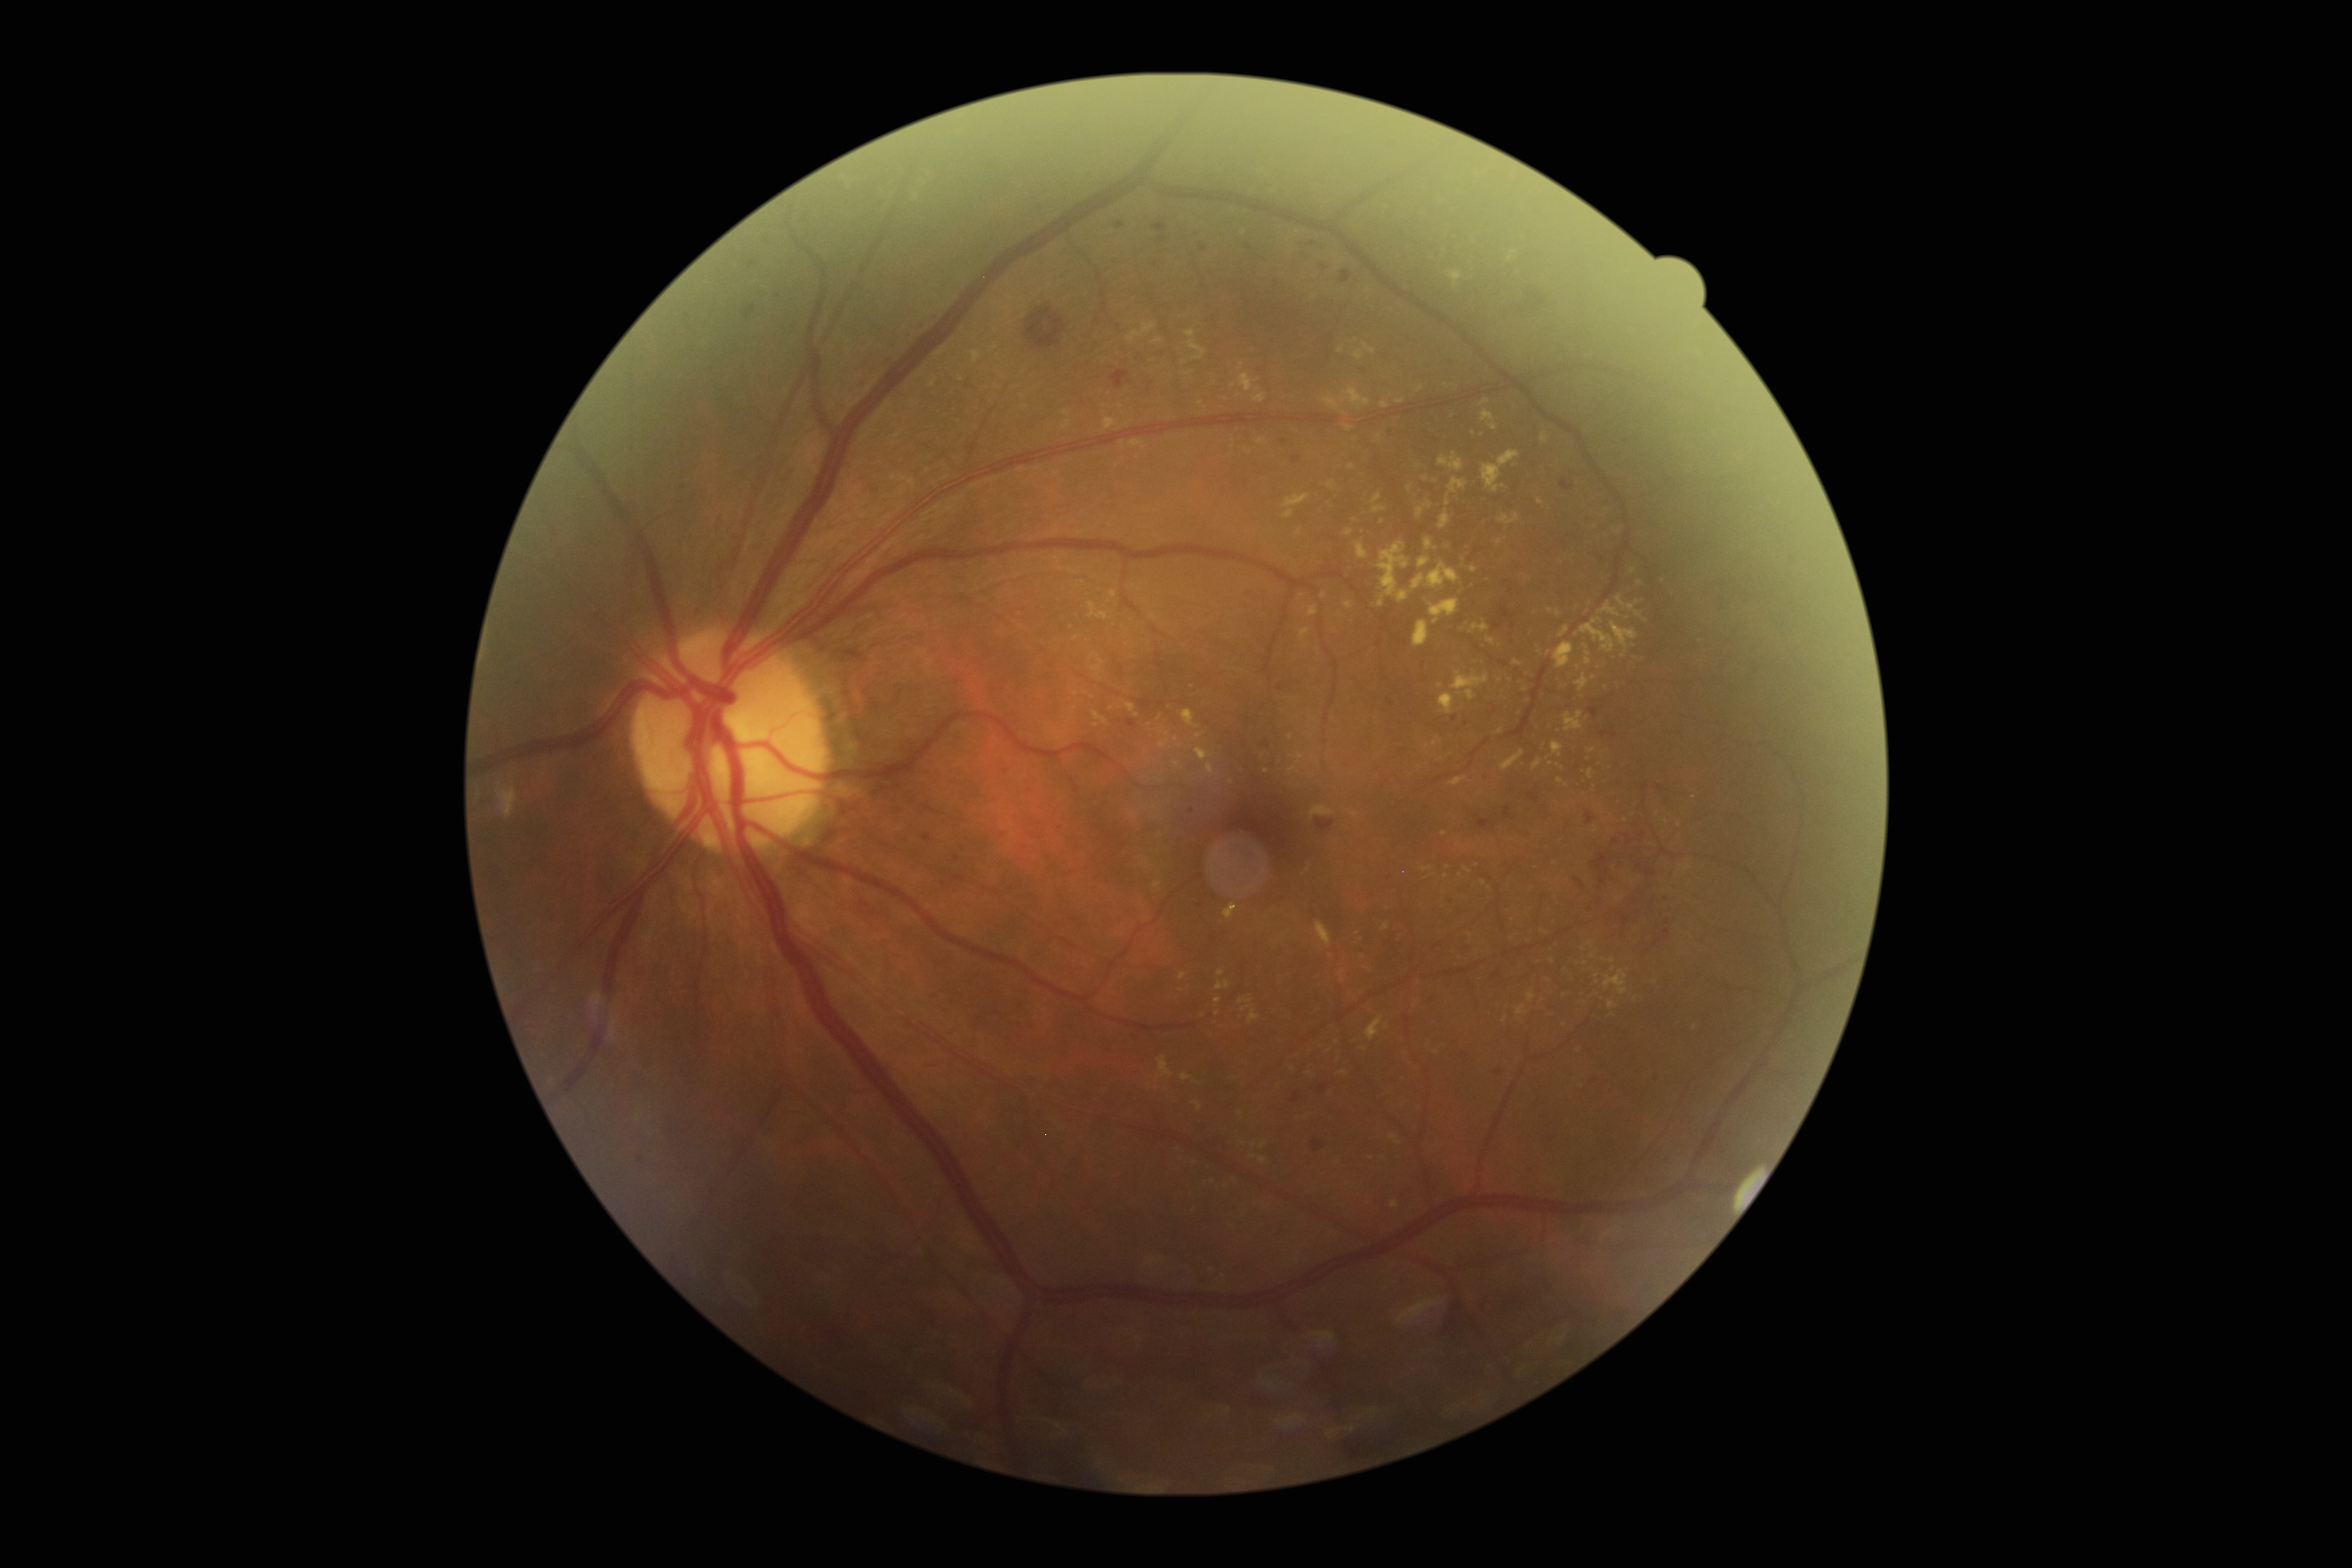
diabetic retinopathy=moderate non-proliferative diabetic retinopathy (grade 2).